Image size 640x480; captured with the Clarity RetCam 3 (130° field of view); wide-field contact fundus photograph of an infant.
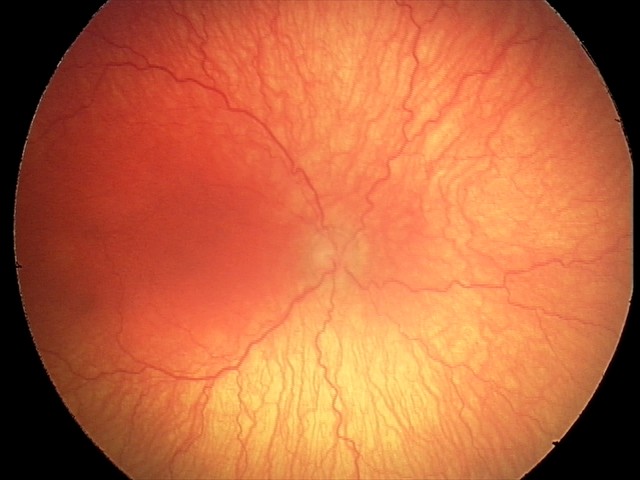

Plus disease present.
Series diagnosed as aggressive retinopathy of prematurity.